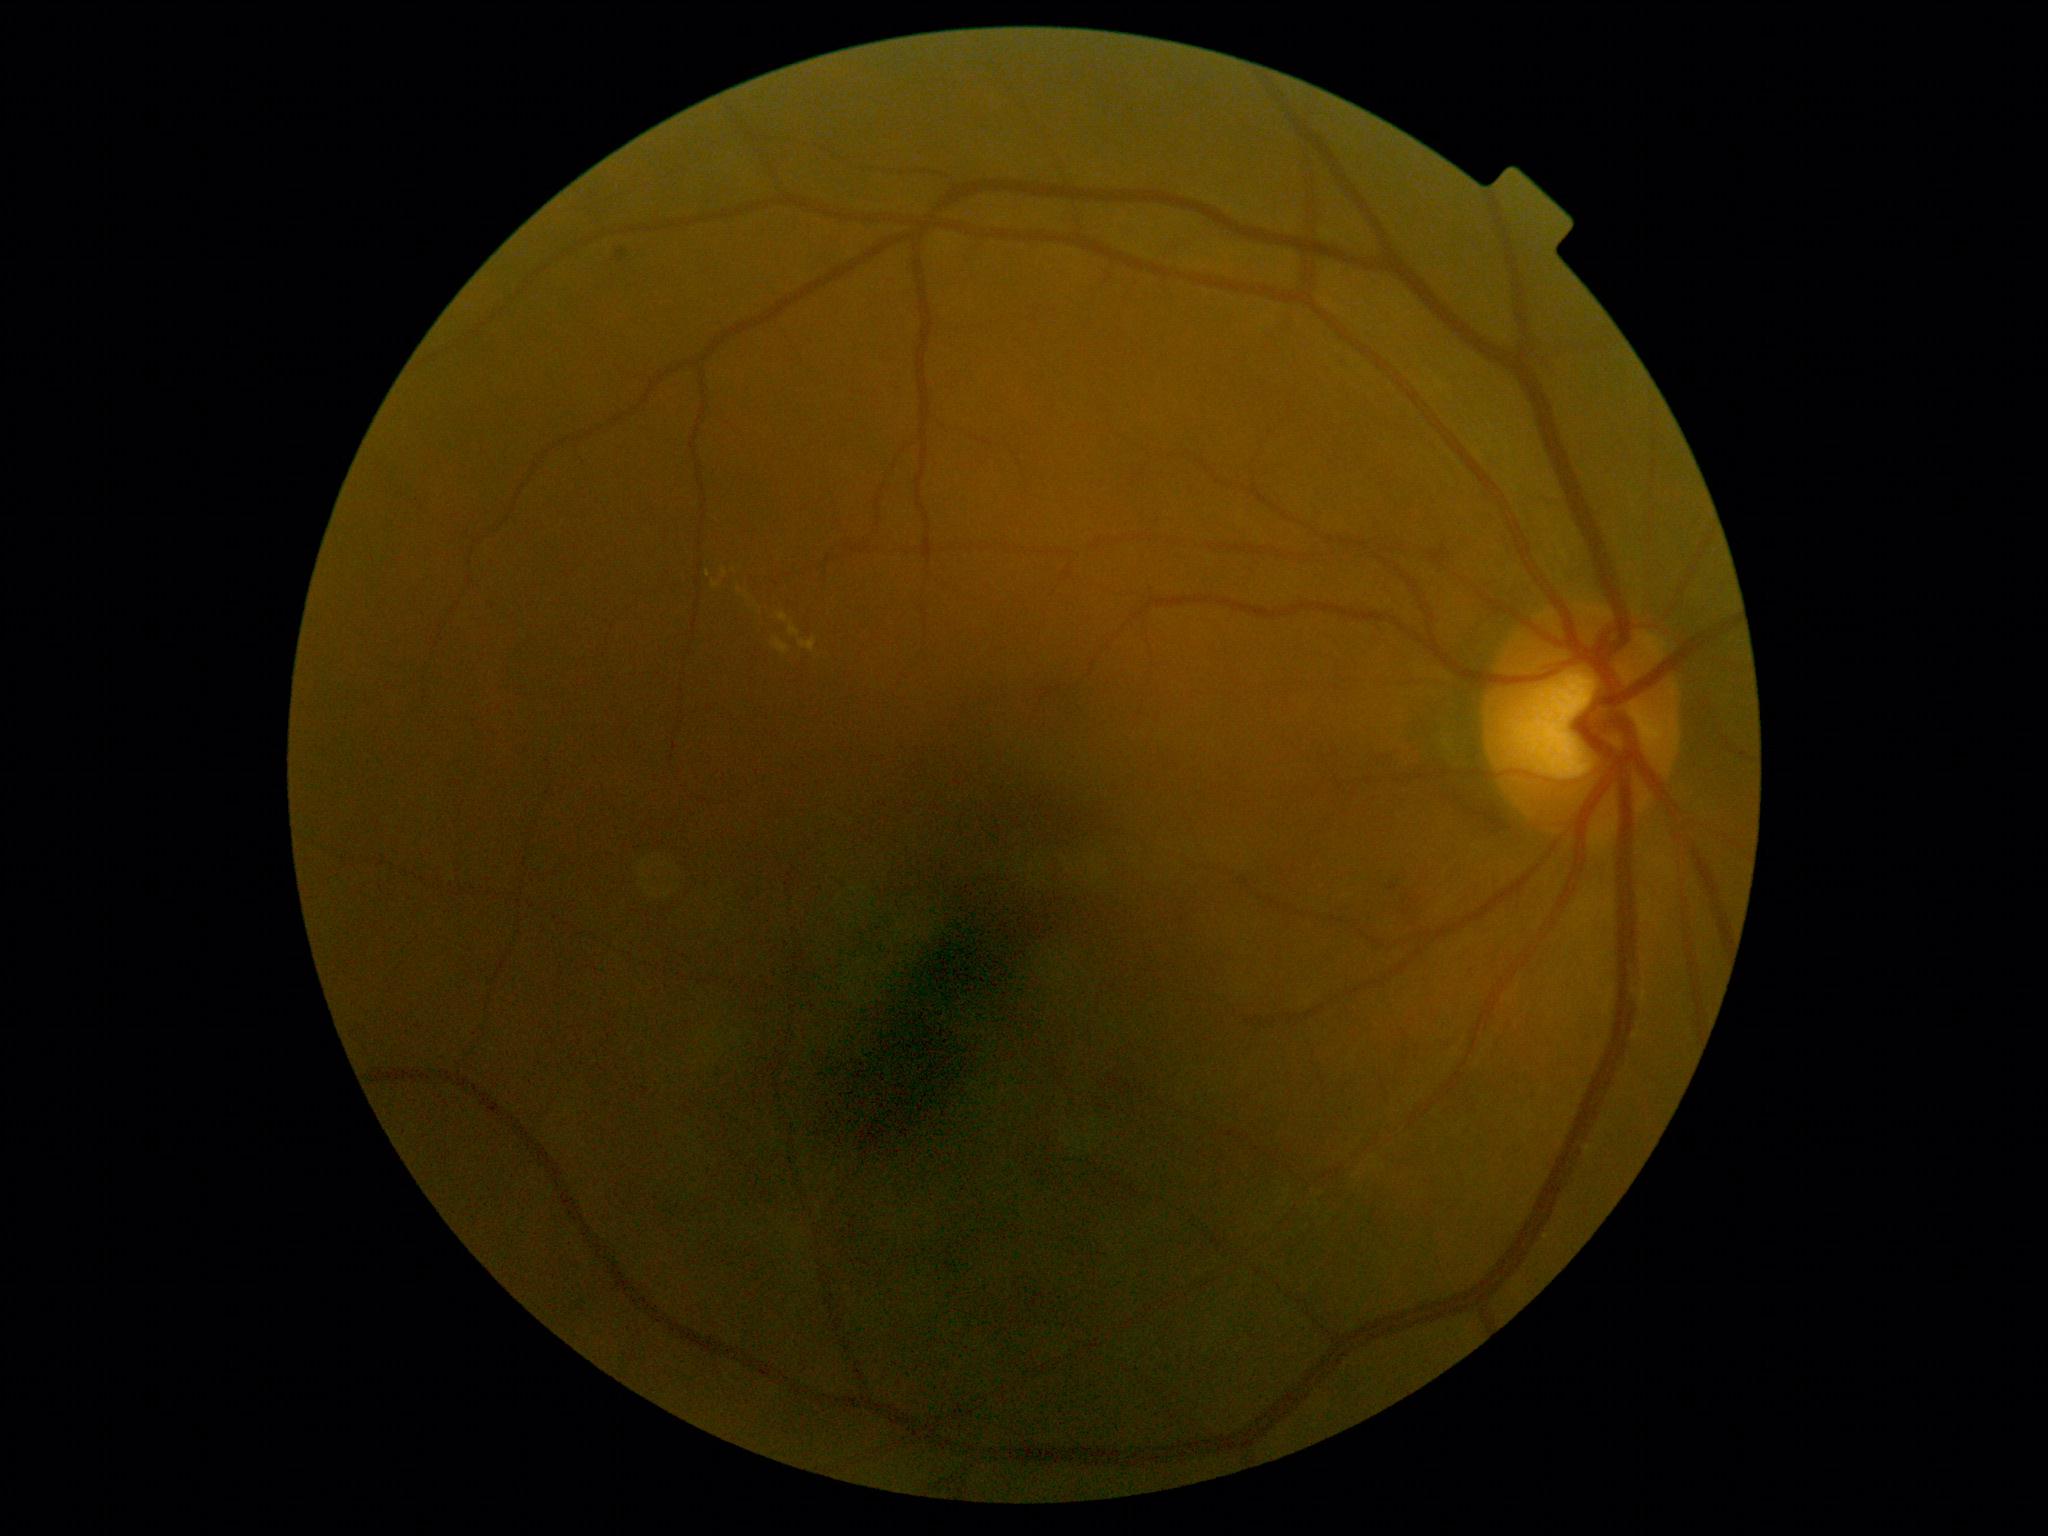
DR is grade 2 (moderate NPDR). Disease class: non-proliferative diabetic retinopathy.